Optic disc photograph
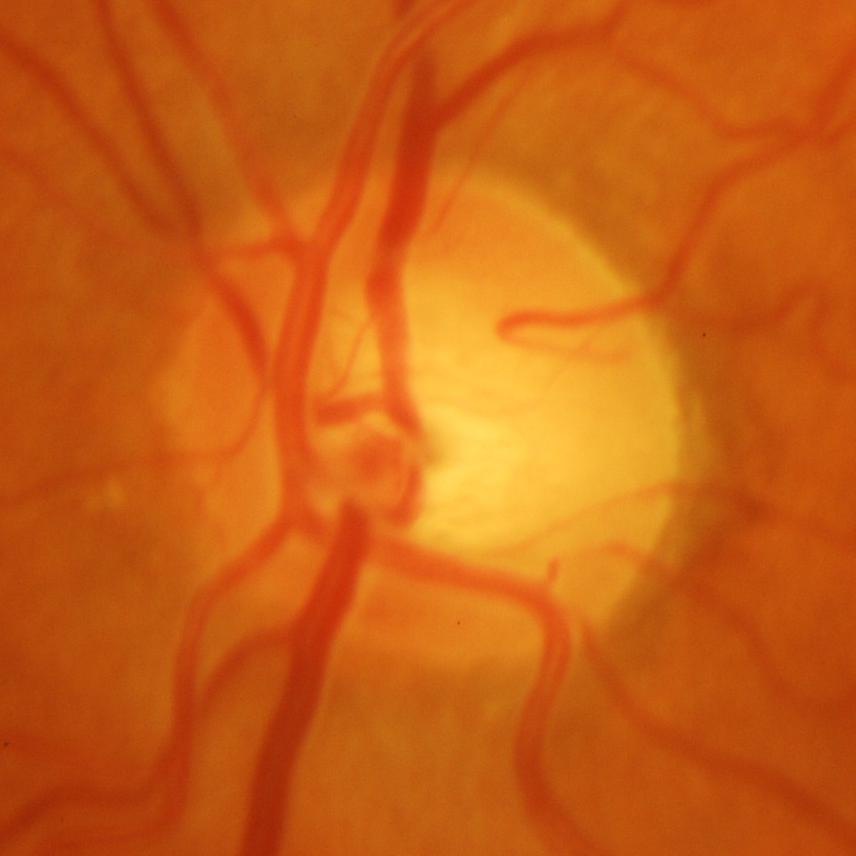
Glaucomatous optic neuropathy is present. Glaucoma diagnosis = glaucomatous findings.